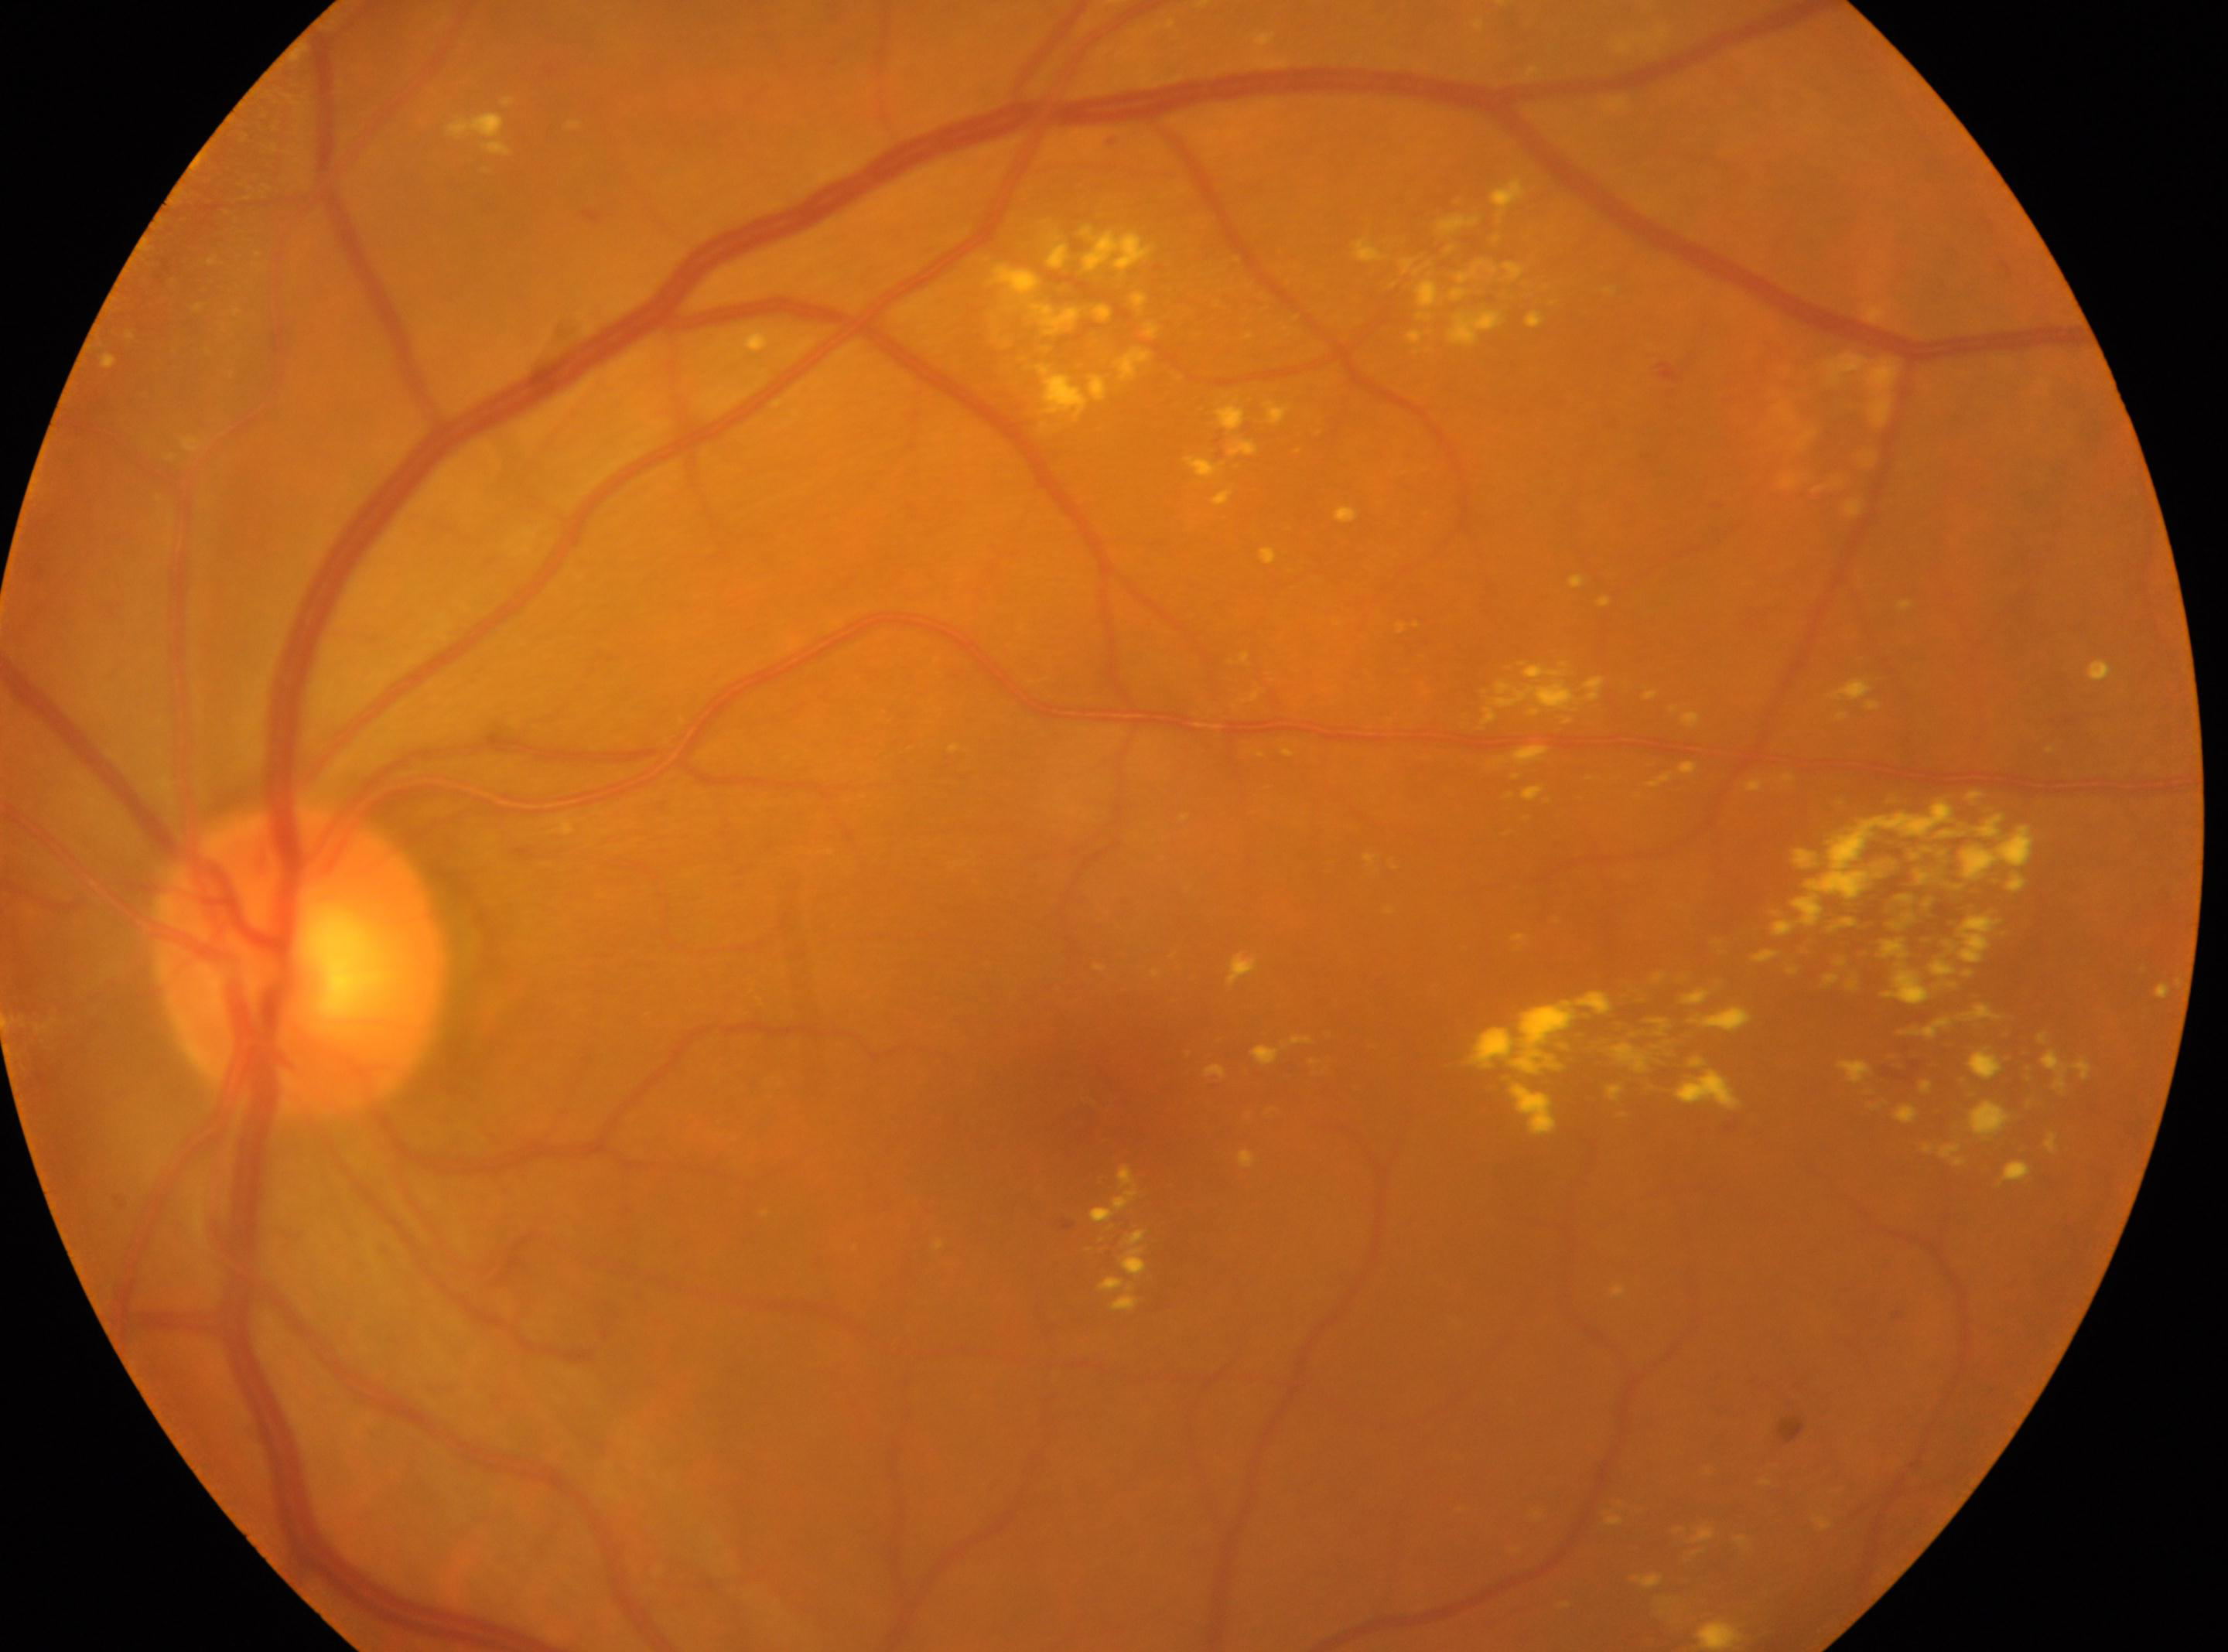

Diabetic retinopathy (DR): 2. Optic disc center: [301, 961]. The retinopathy is classified as non-proliferative diabetic retinopathy. Imaged eye: left. Fovea: [1117, 1117].